Captured with the Phoenix ICON (100° field of view). Infant wide-field retinal image.
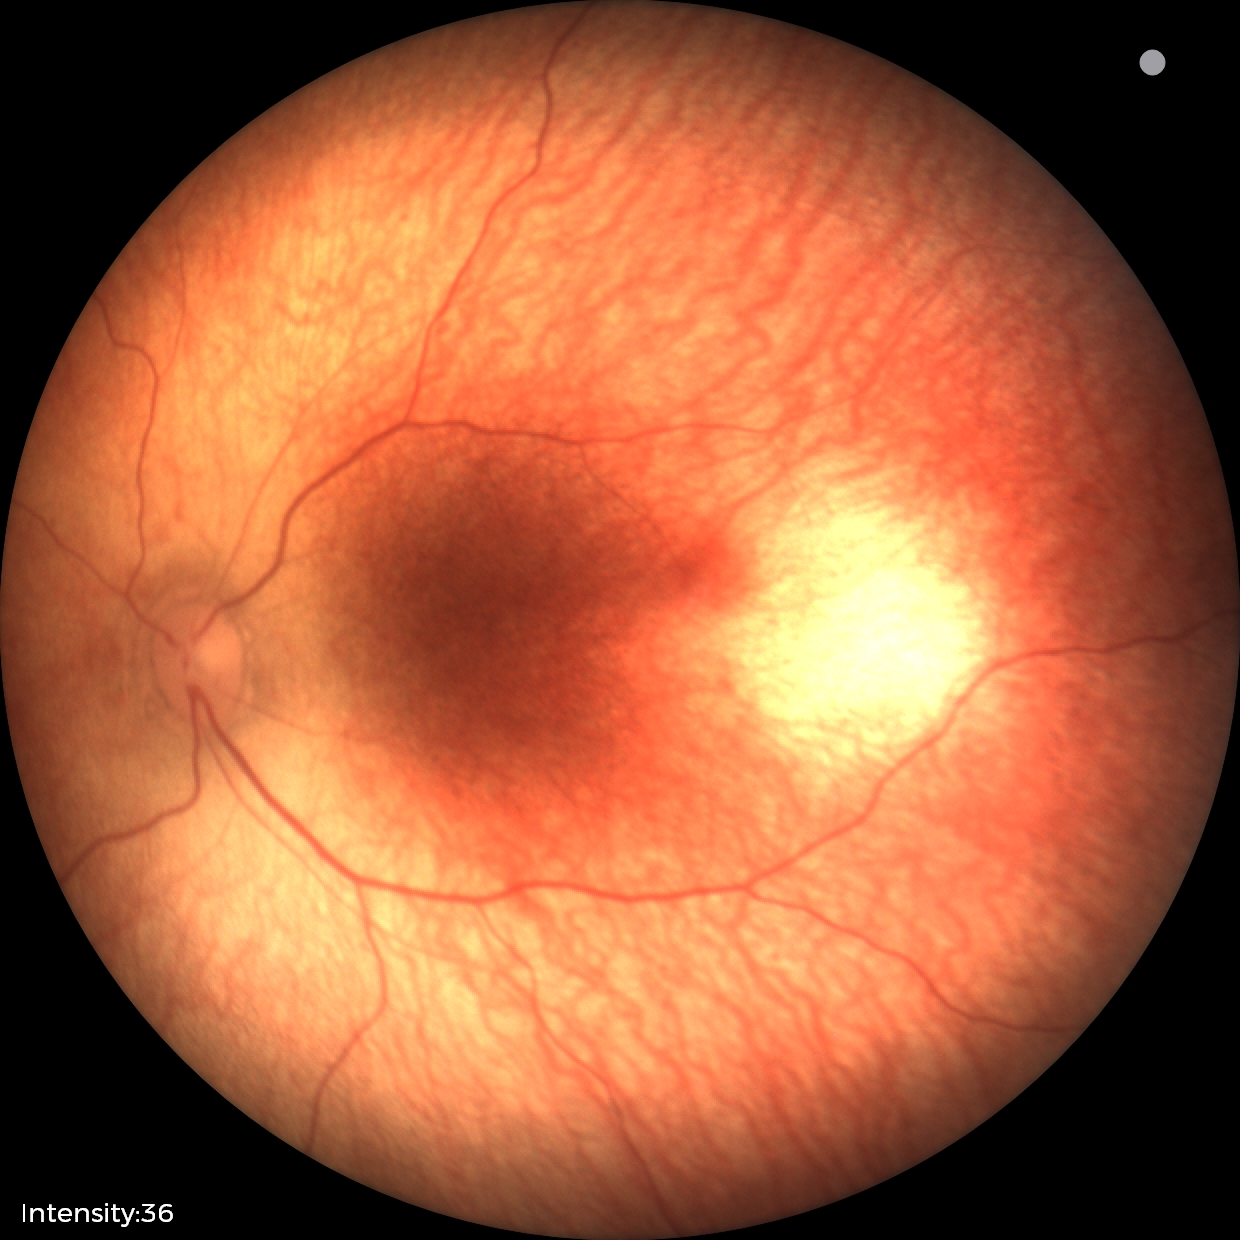 Screening examination with no abnormal retinal findings.